Fundus photograph cropped around the optic nerve head:
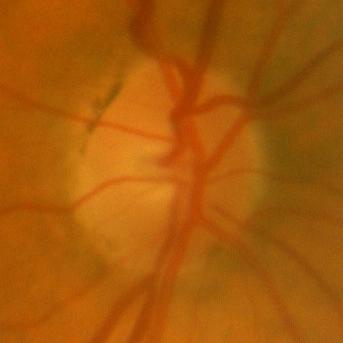
There is evidence of no glaucomatous findings.